2361 x 1568 pixels: 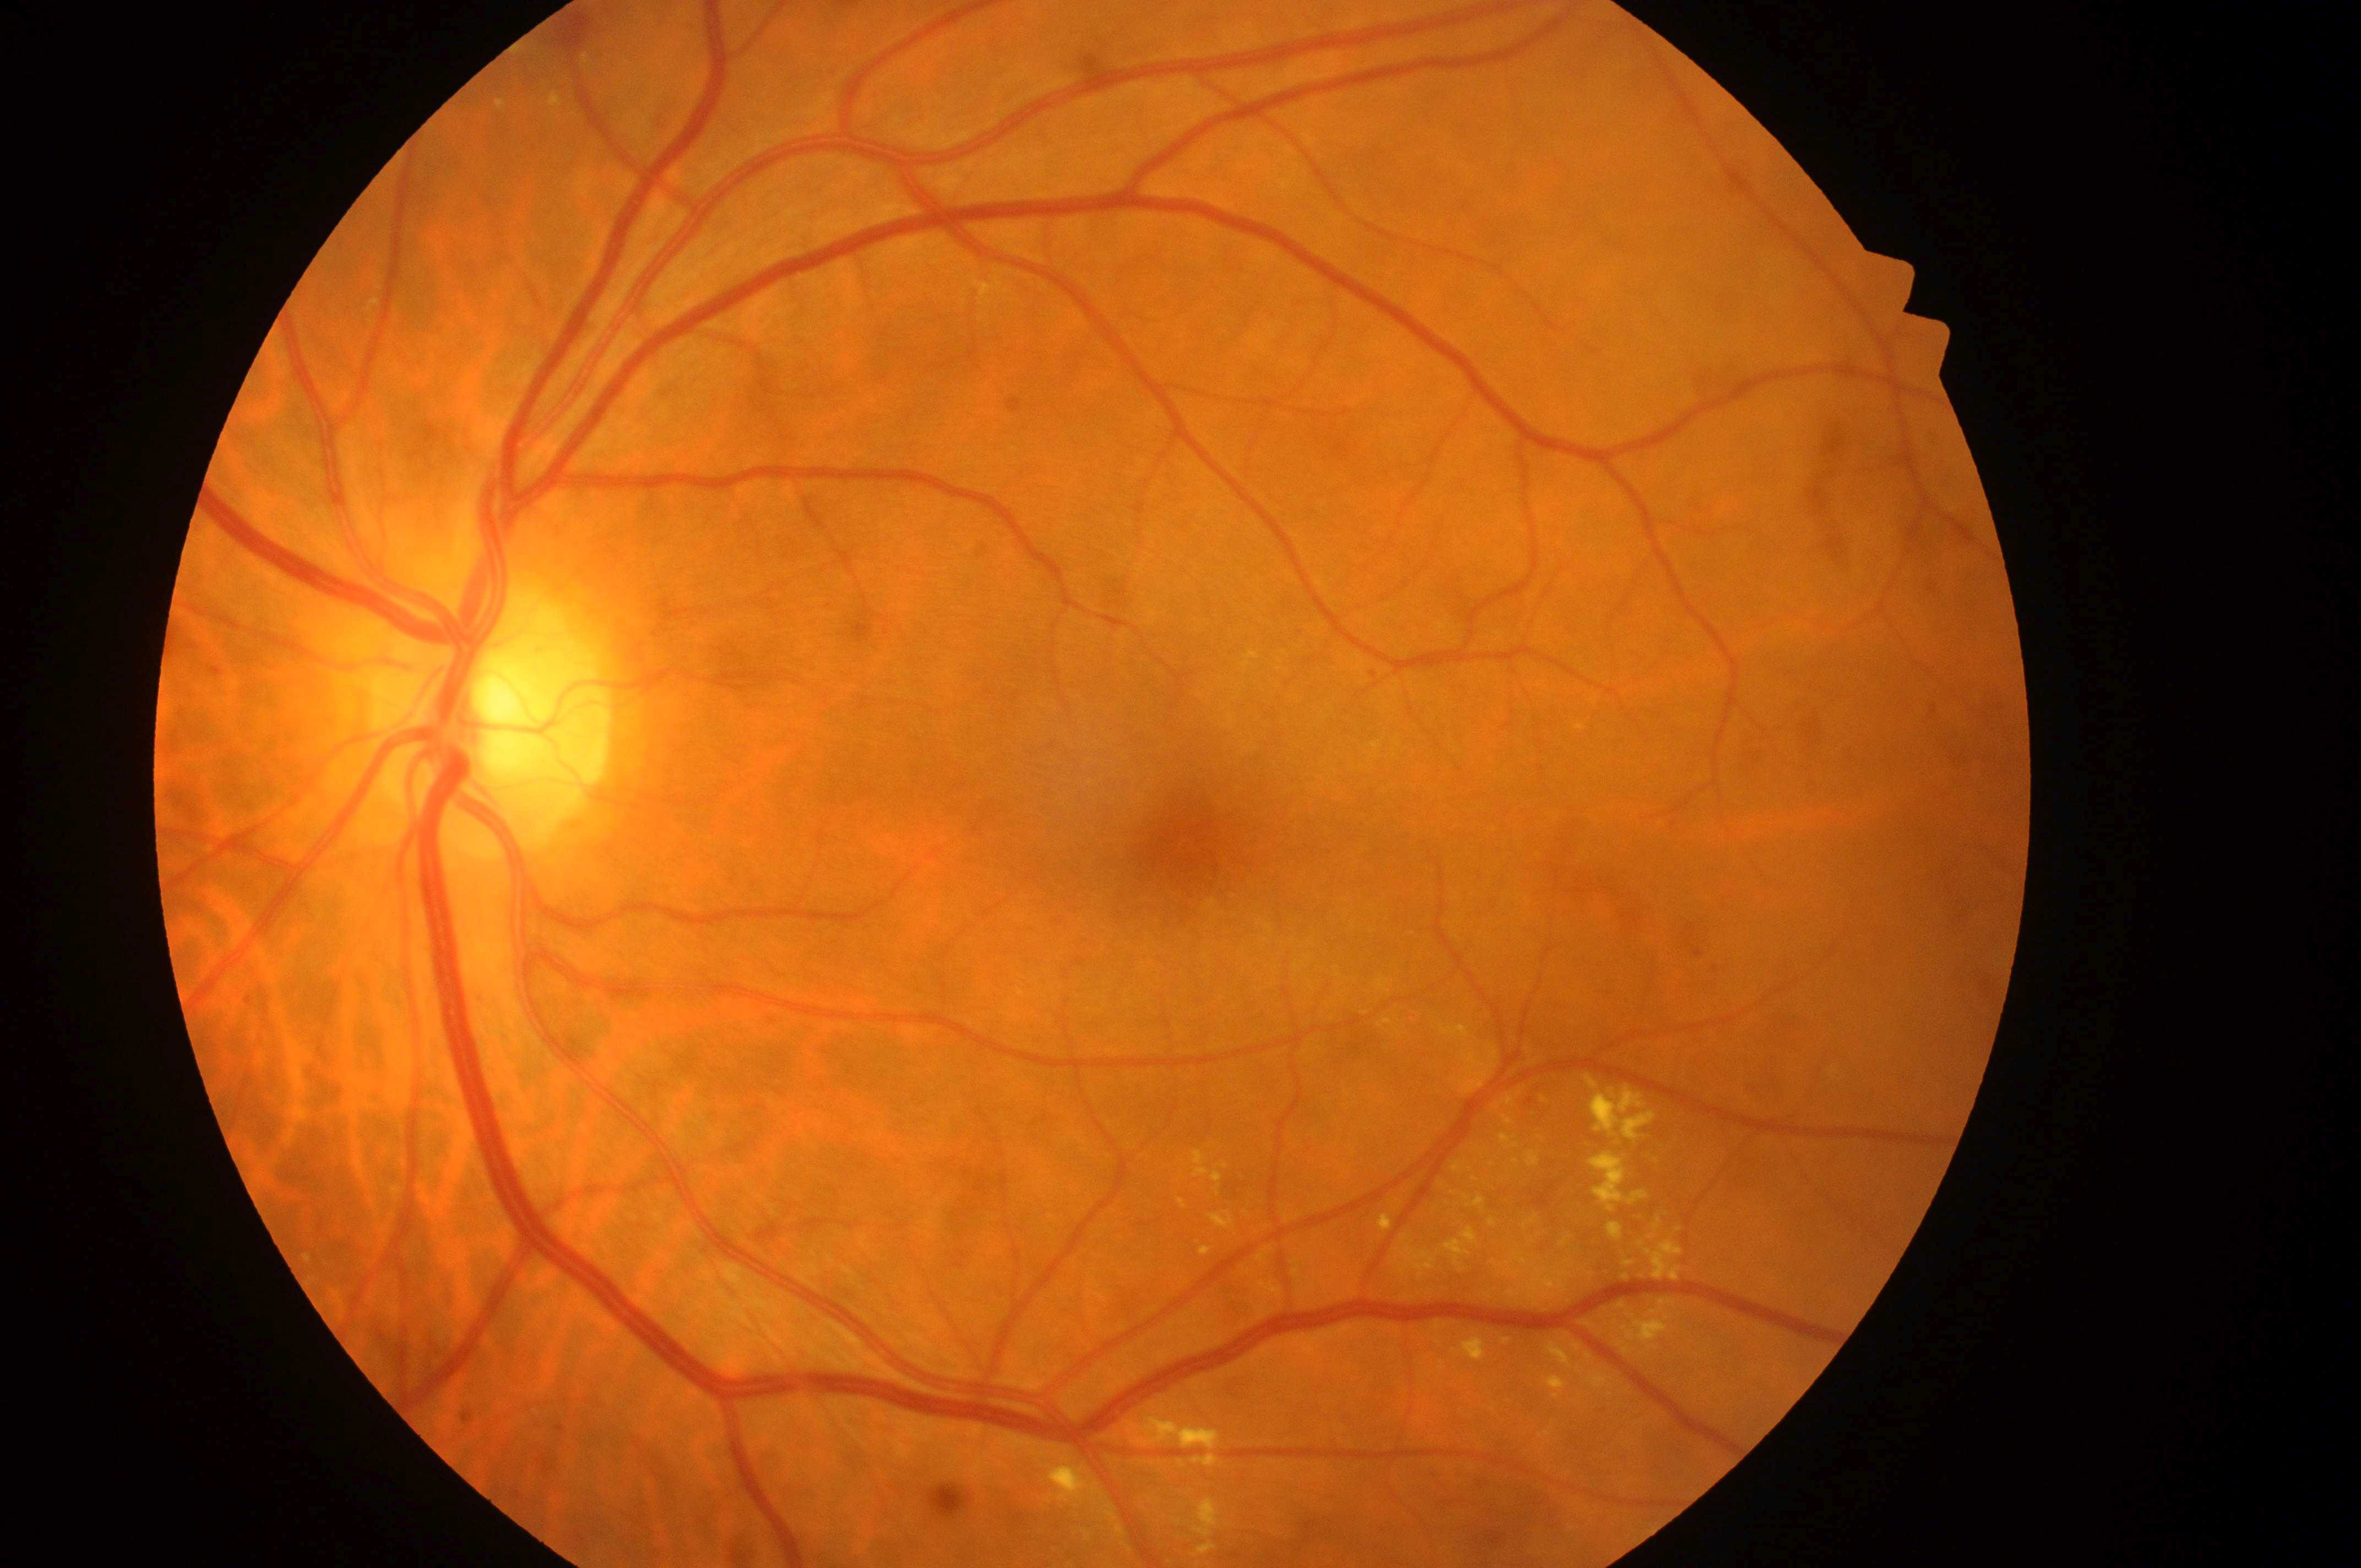 laterality = the left eye
macular center = 1190px, 843px
optic disc = 485px, 723px
macular edema = 1
retinopathy grade = 2